Pediatric retinal photograph (wide-field): 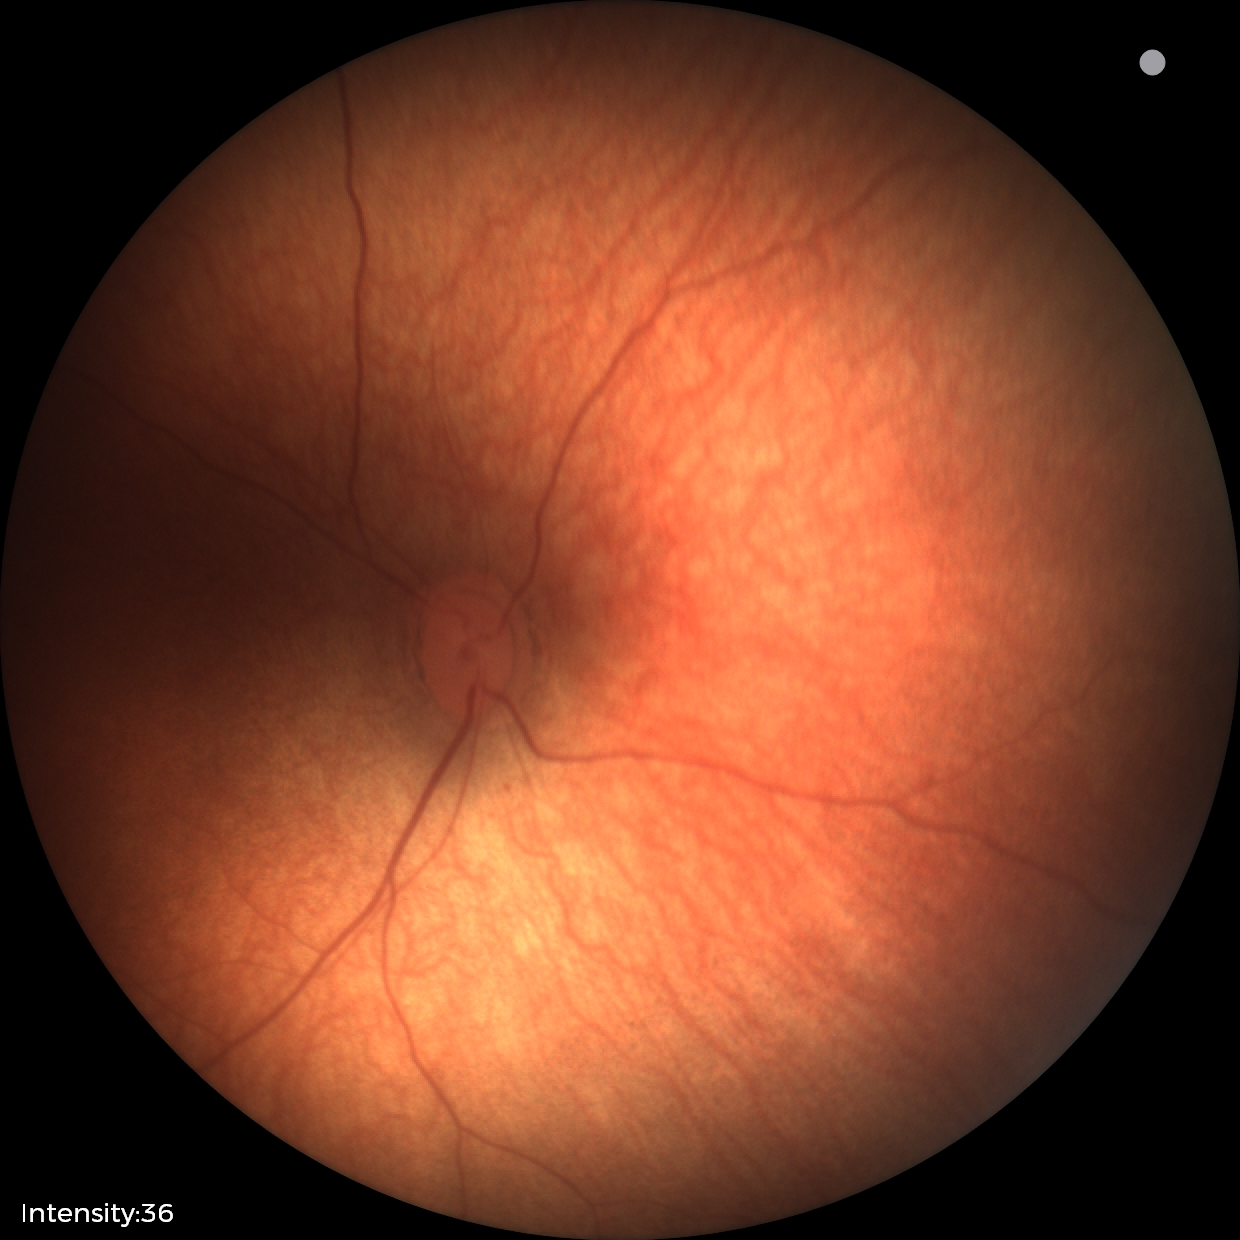
No retinal pathology identified on screening.